RetCam wide-field infant fundus image. Clarity RetCam 3, 130° FOV. 640 by 480 pixels — 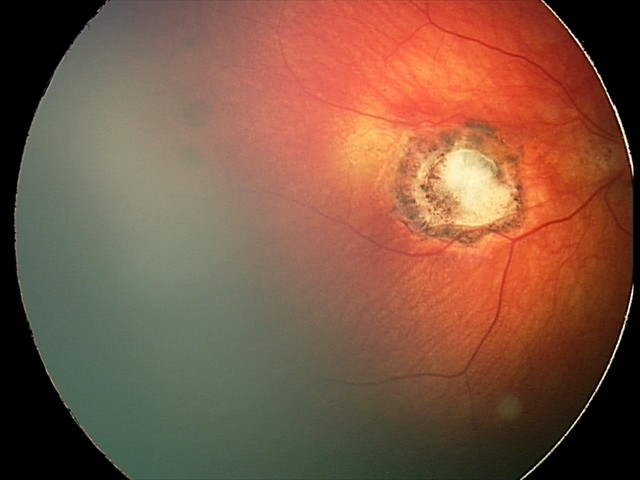

Assessment = toxoplasmosis chorioretinitis